Fundus photo; image size 240x240
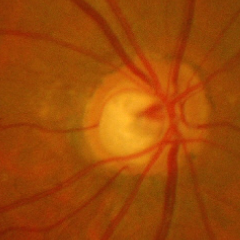 Glaucomatous changes are present. There is evidence of advanced glaucoma.